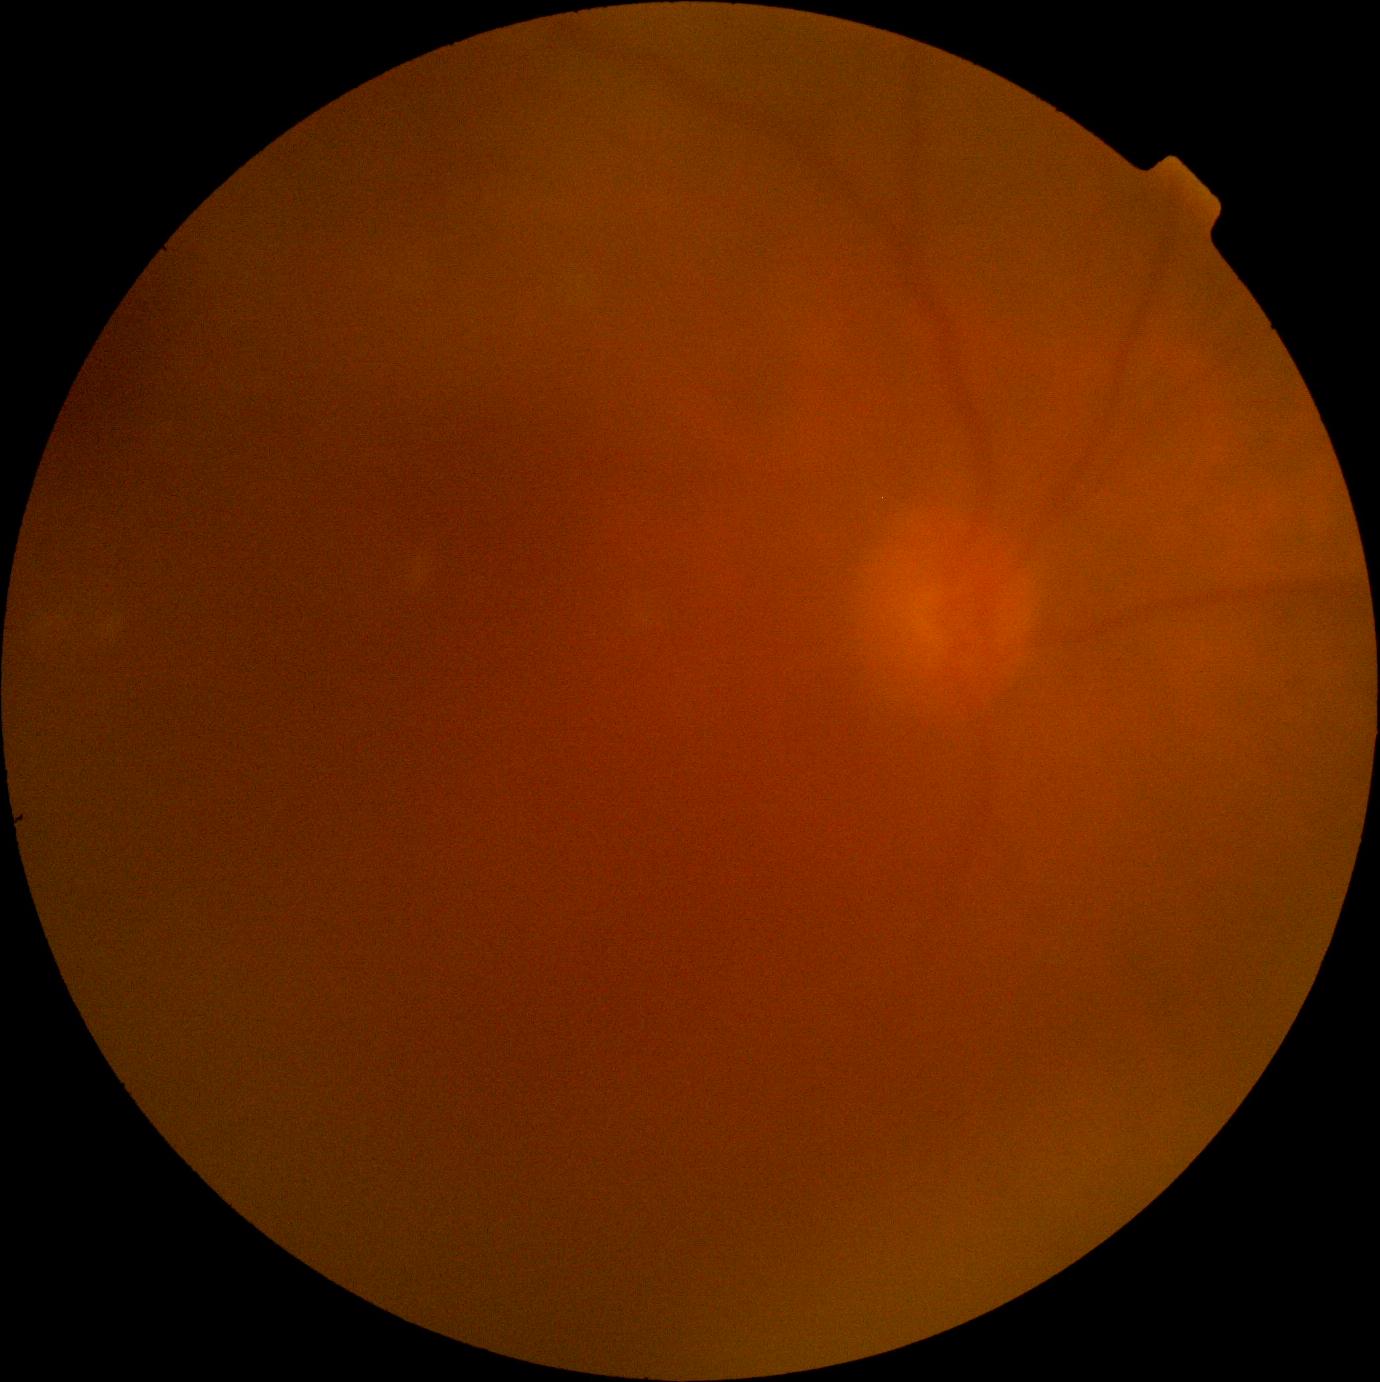

Diabetic retinopathy (DR): ungradable.